Infant wide-field fundus photograph; 1240 by 1240 pixels: 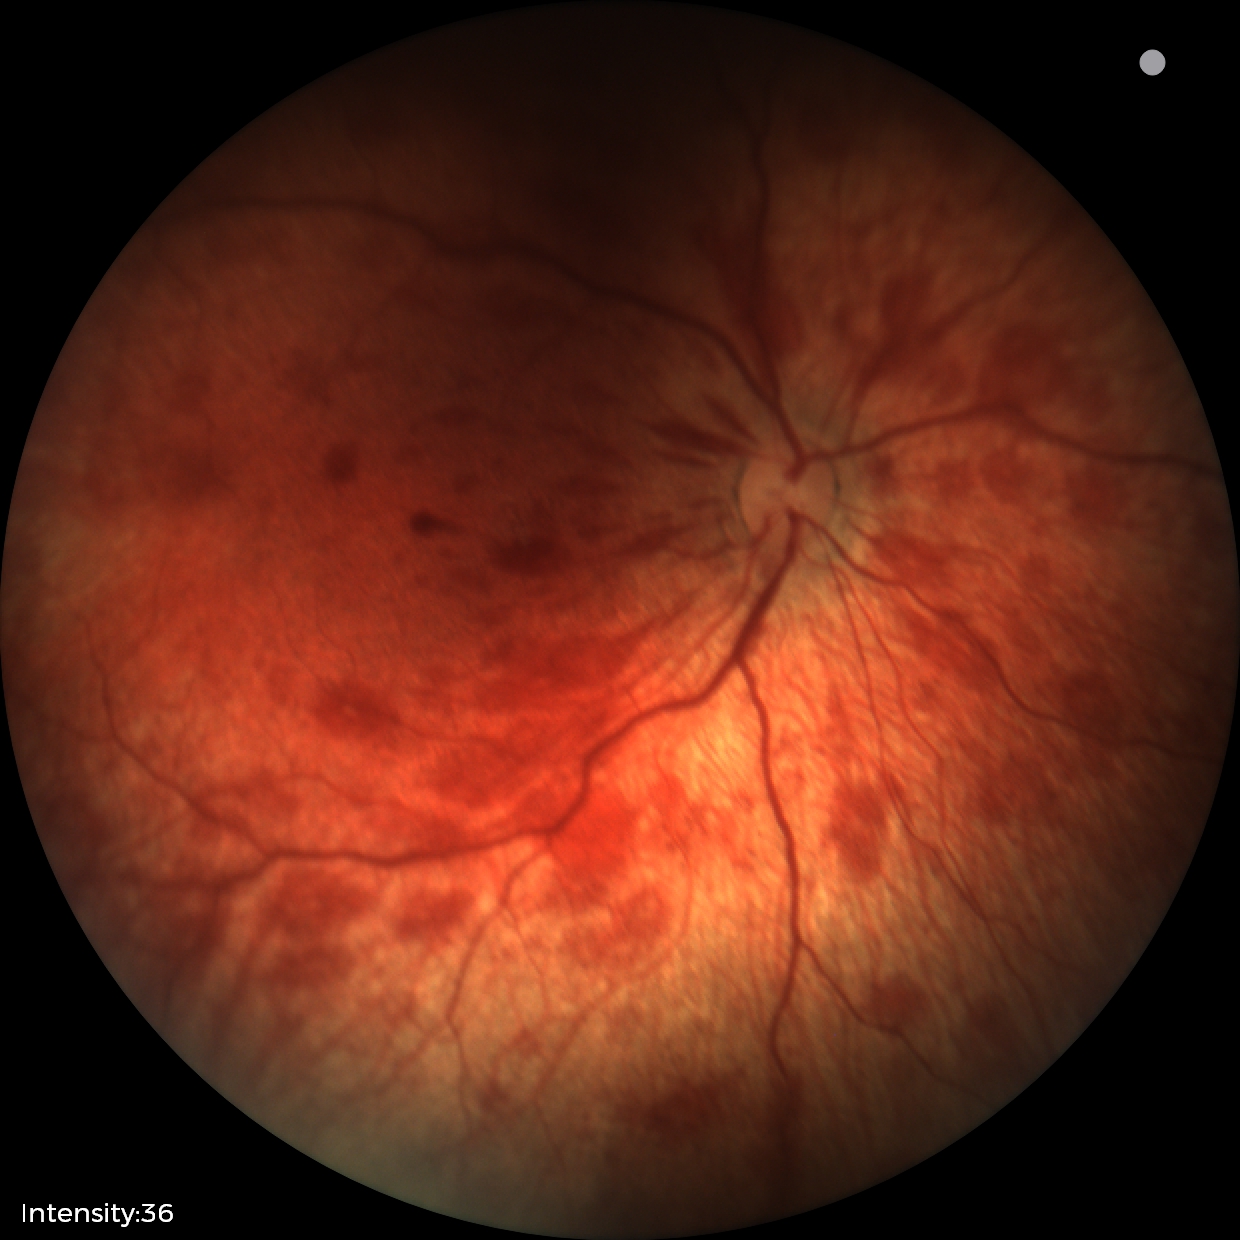

Screening diagnosis: retinal hemorrhages.